640 x 480 pixels; infant wide-field fundus photograph
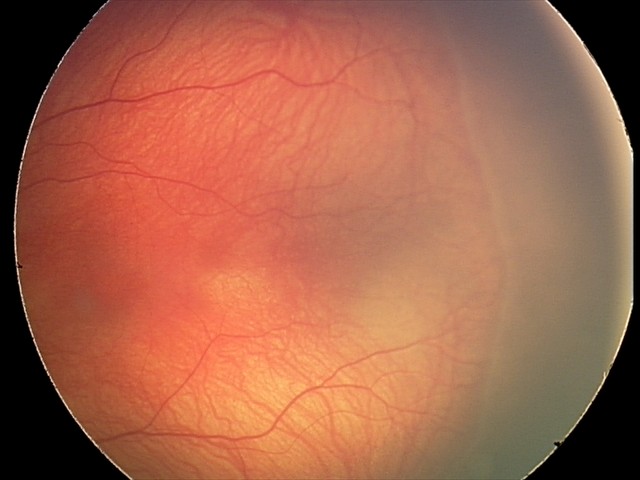 Plus disease absent. From an examination with diagnosis of retinopathy of prematurity stage 2.